Diabetic retinopathy graded by the modified Davis classification.
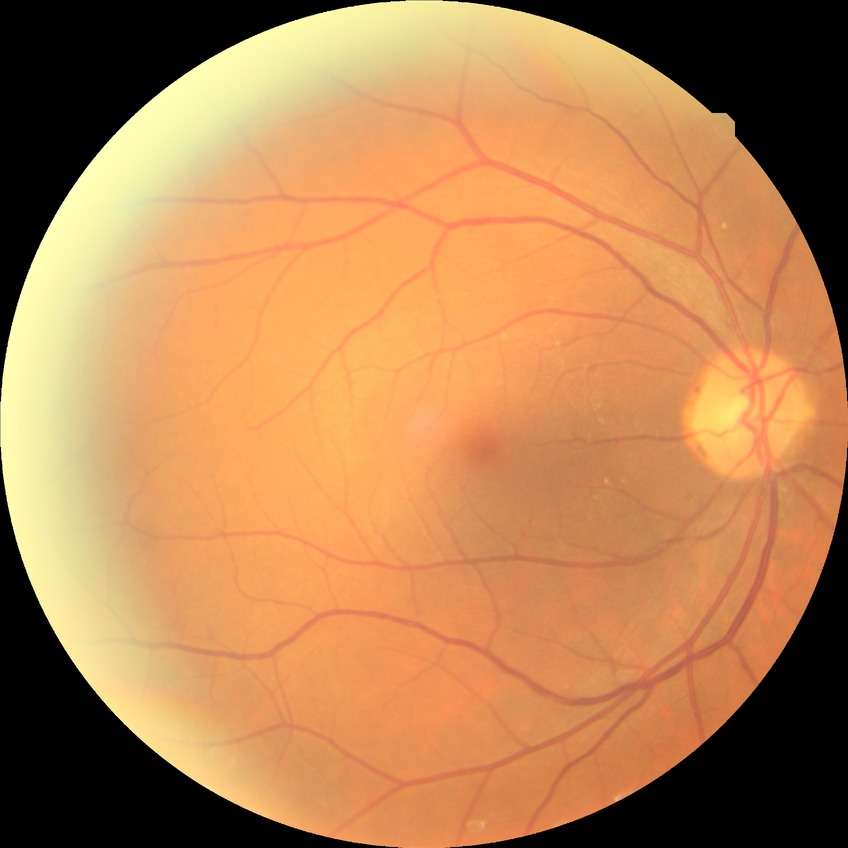
diabetic retinopathy (DR): no diabetic retinopathy (NDR).